130° field of view (Clarity RetCam 3) · wide-field fundus photograph of an infant · image size 640x480.
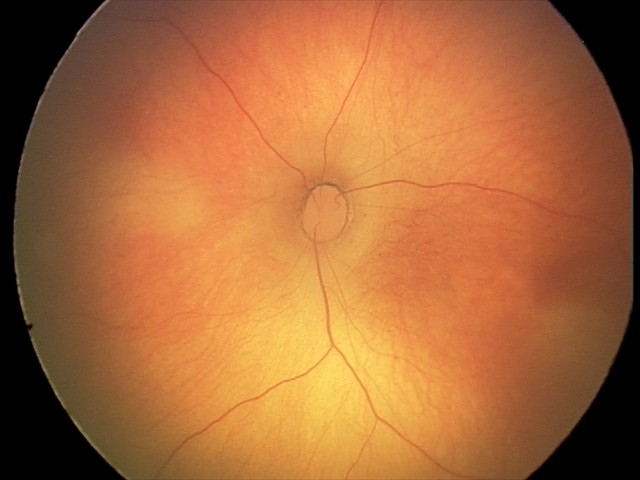 Diagnosis: no pathology identified.